2352 x 1568 pixels. 45-degree field of view. Retinal fundus photograph.
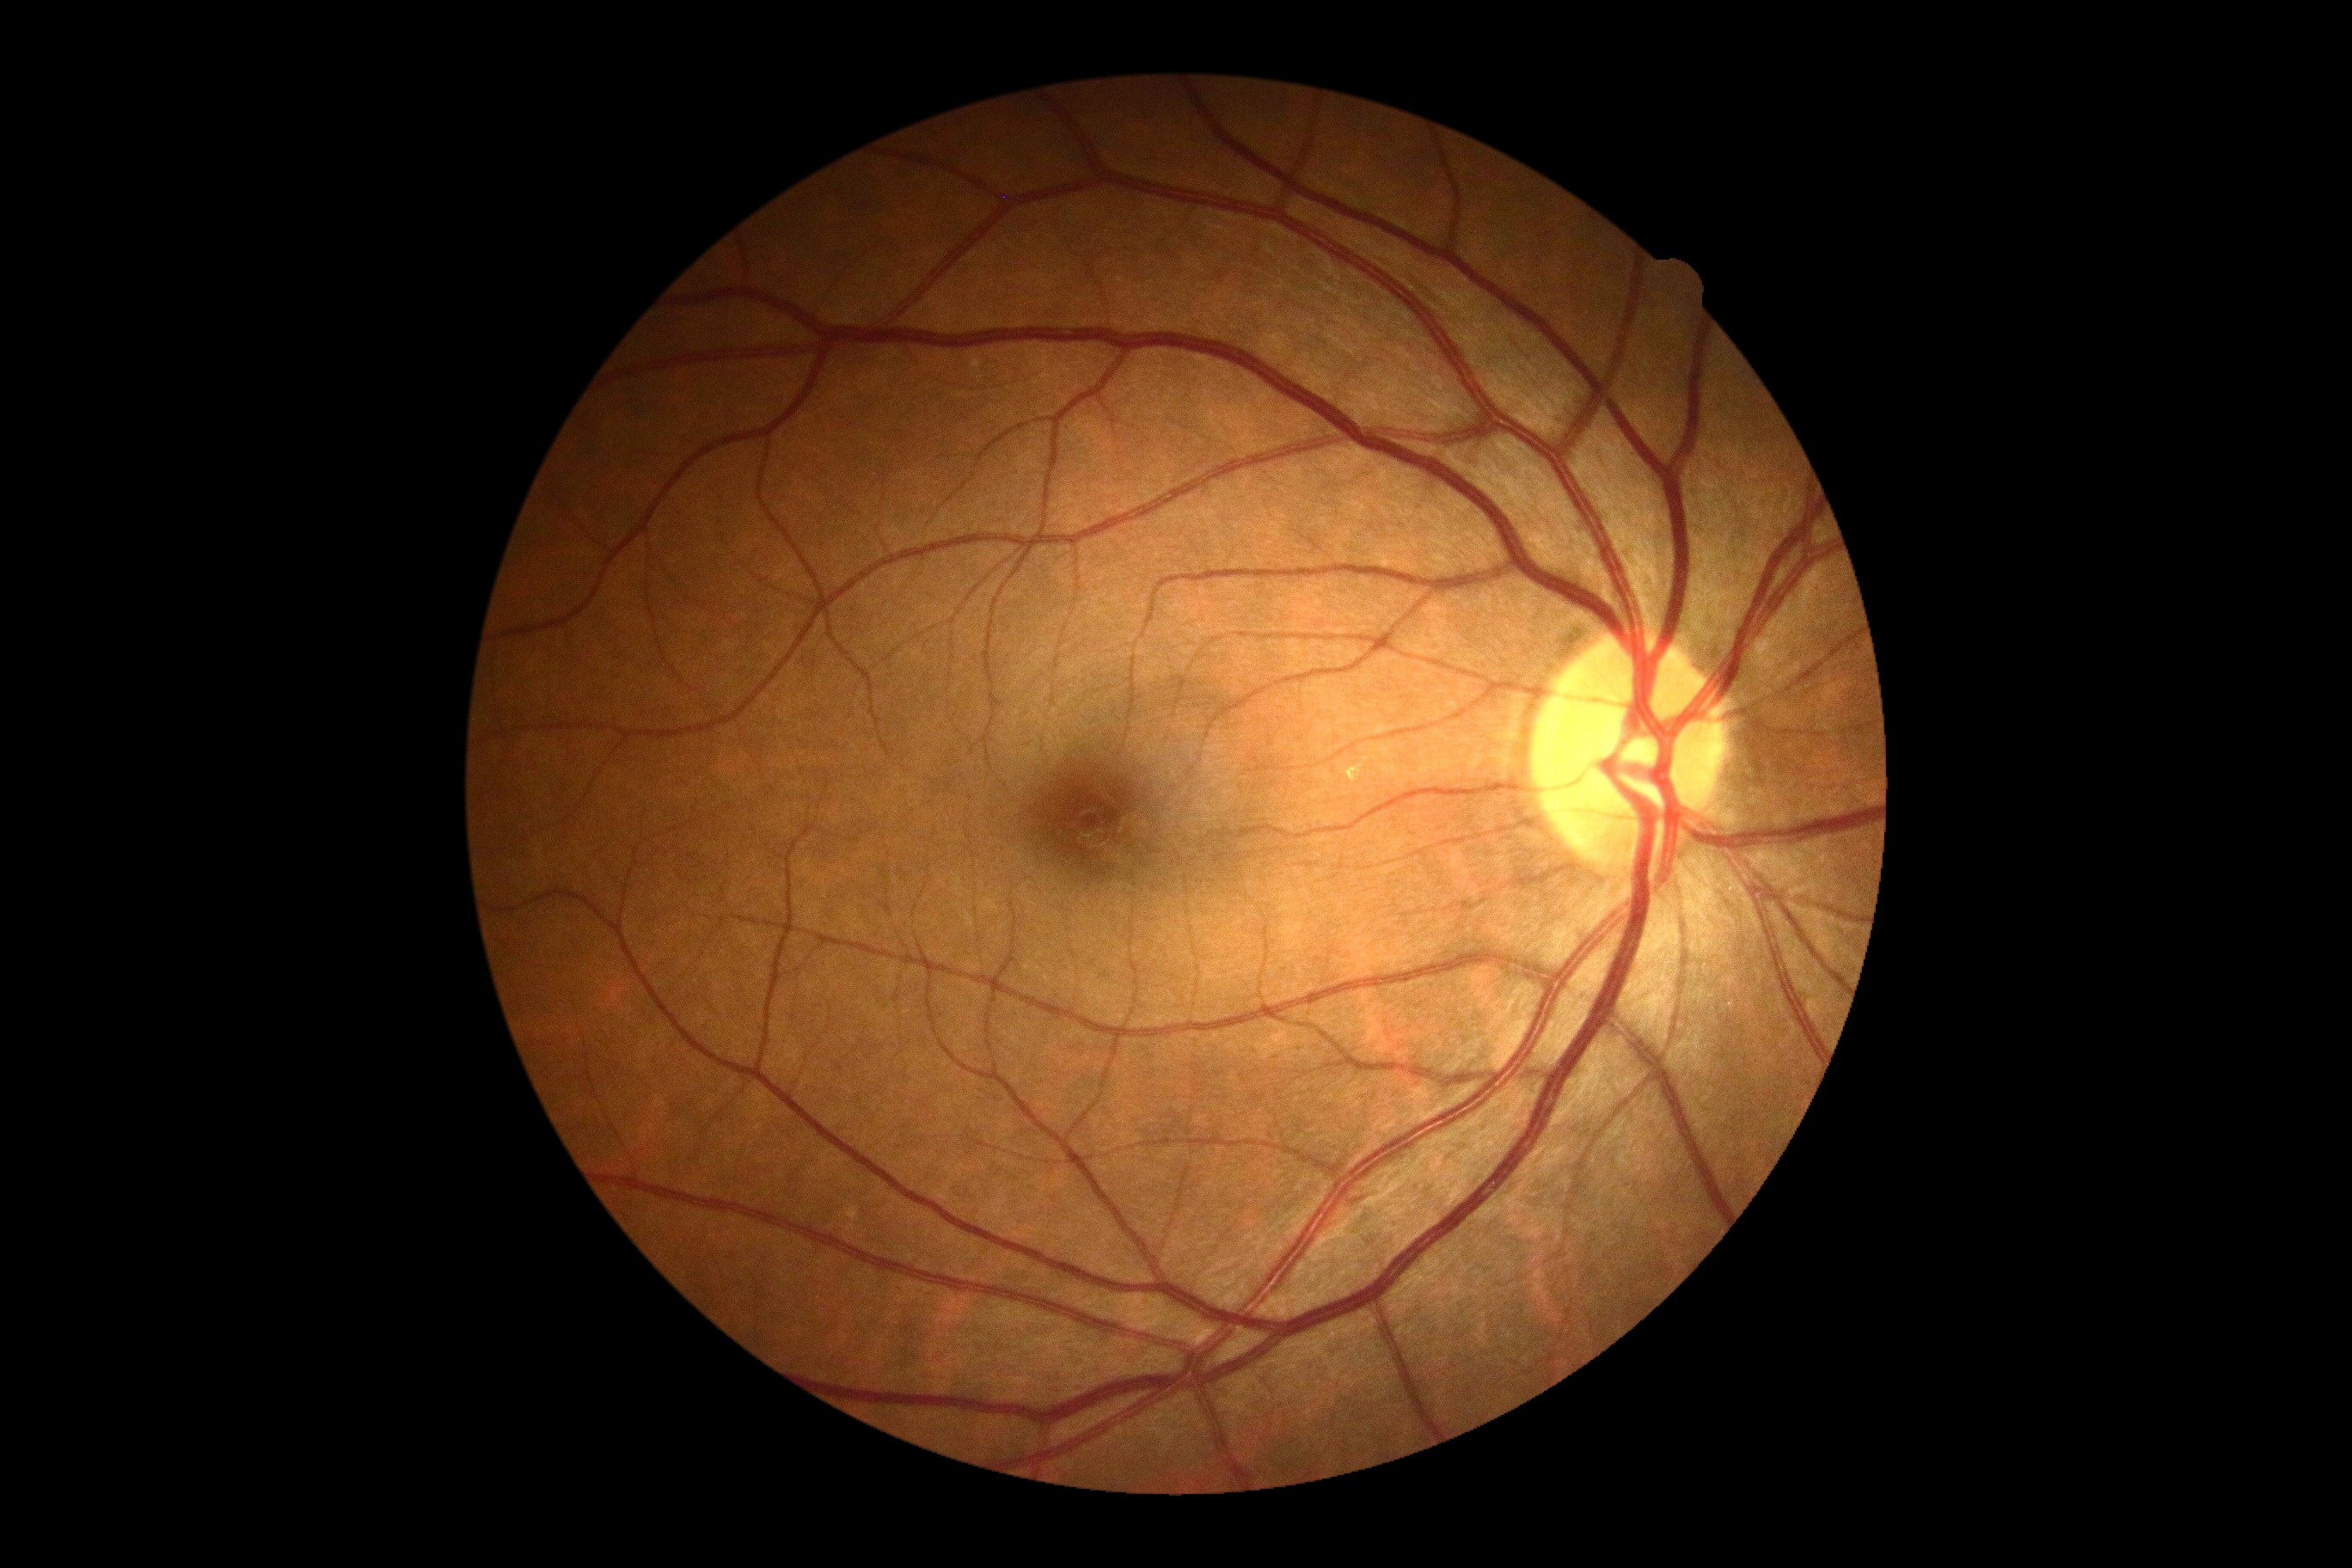

Diabetic retinopathy (DR) is 0.